Wide-field fundus photograph of an infant; 1440x1080: 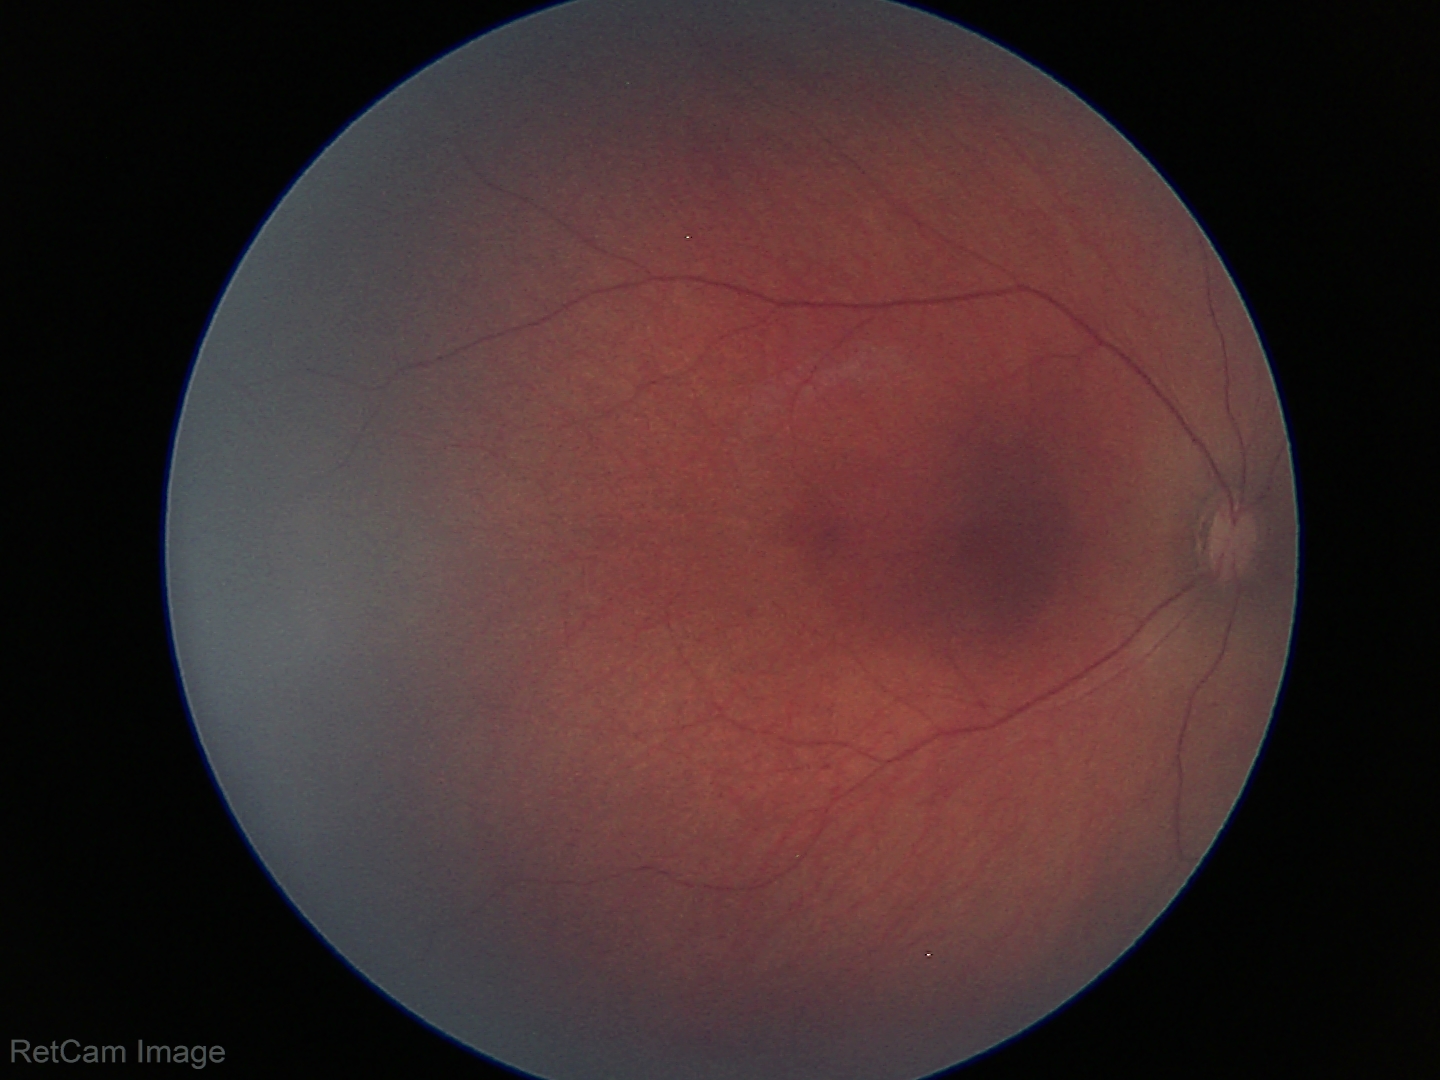 No retinal pathology identified on screening.